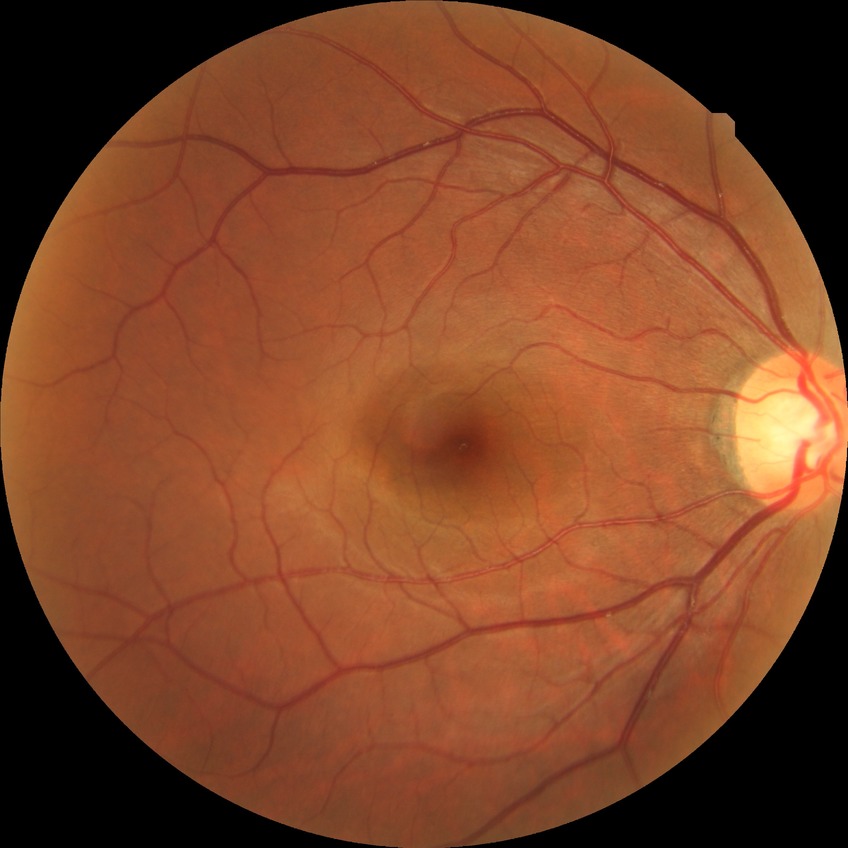
Findings:
- modified Davis grade: NDR
- DR impression: no DR findings